Wide-field fundus photograph of an infant; 1440x1080px; acquired on the Natus RetCam Envision.
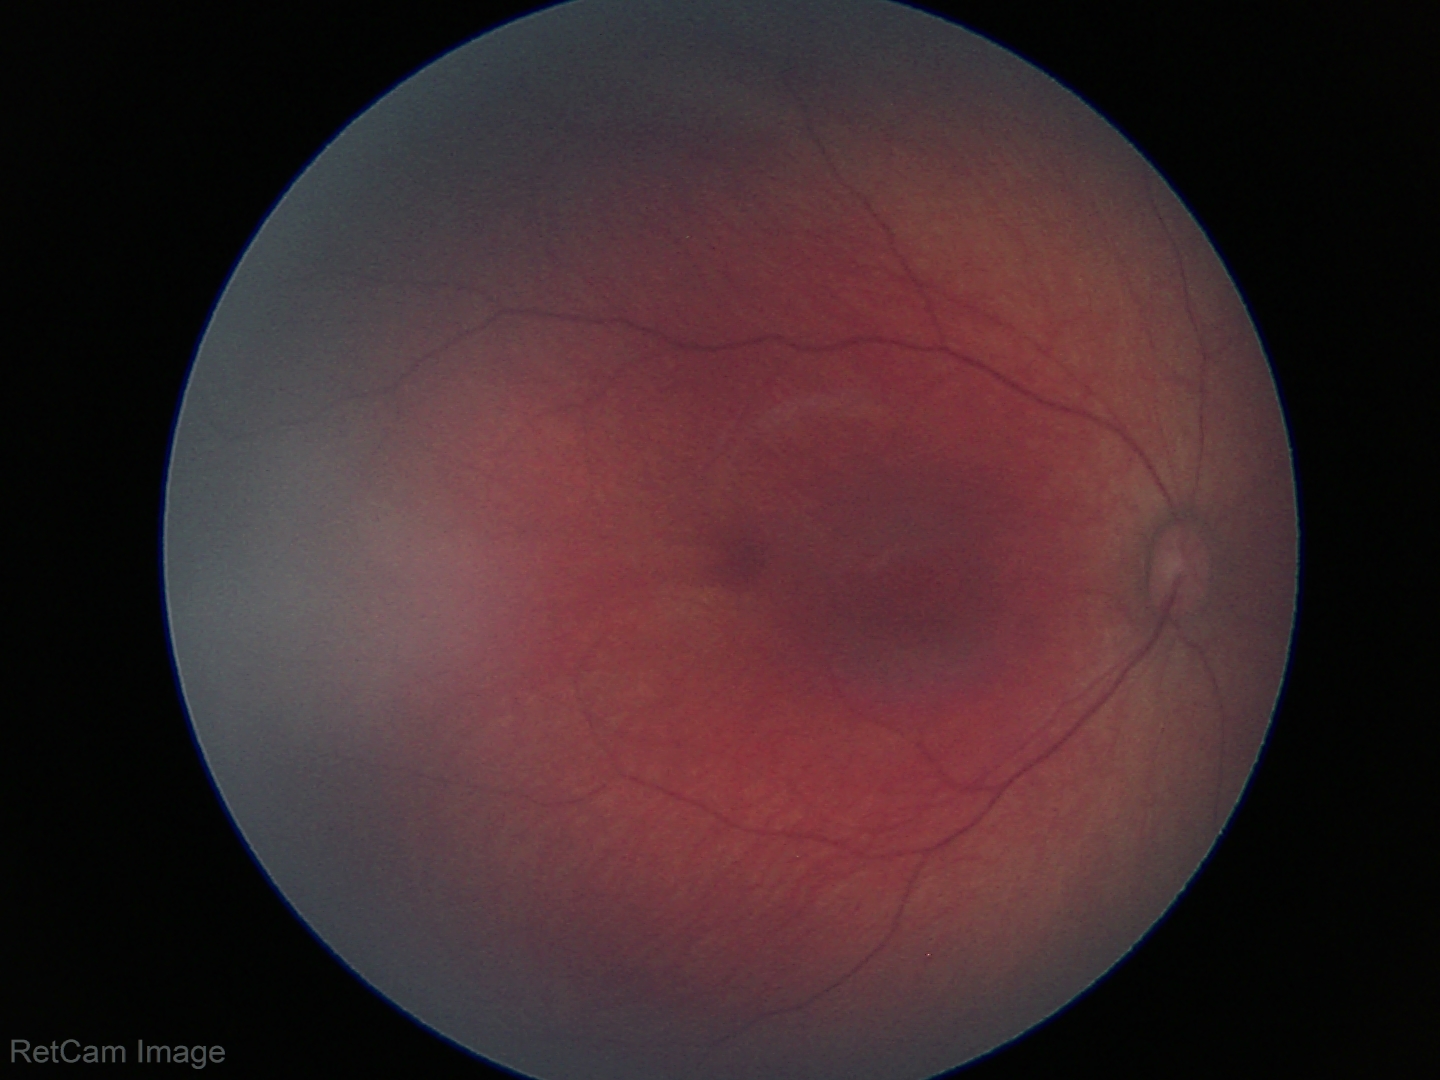 Diagnosis = no abnormalities.